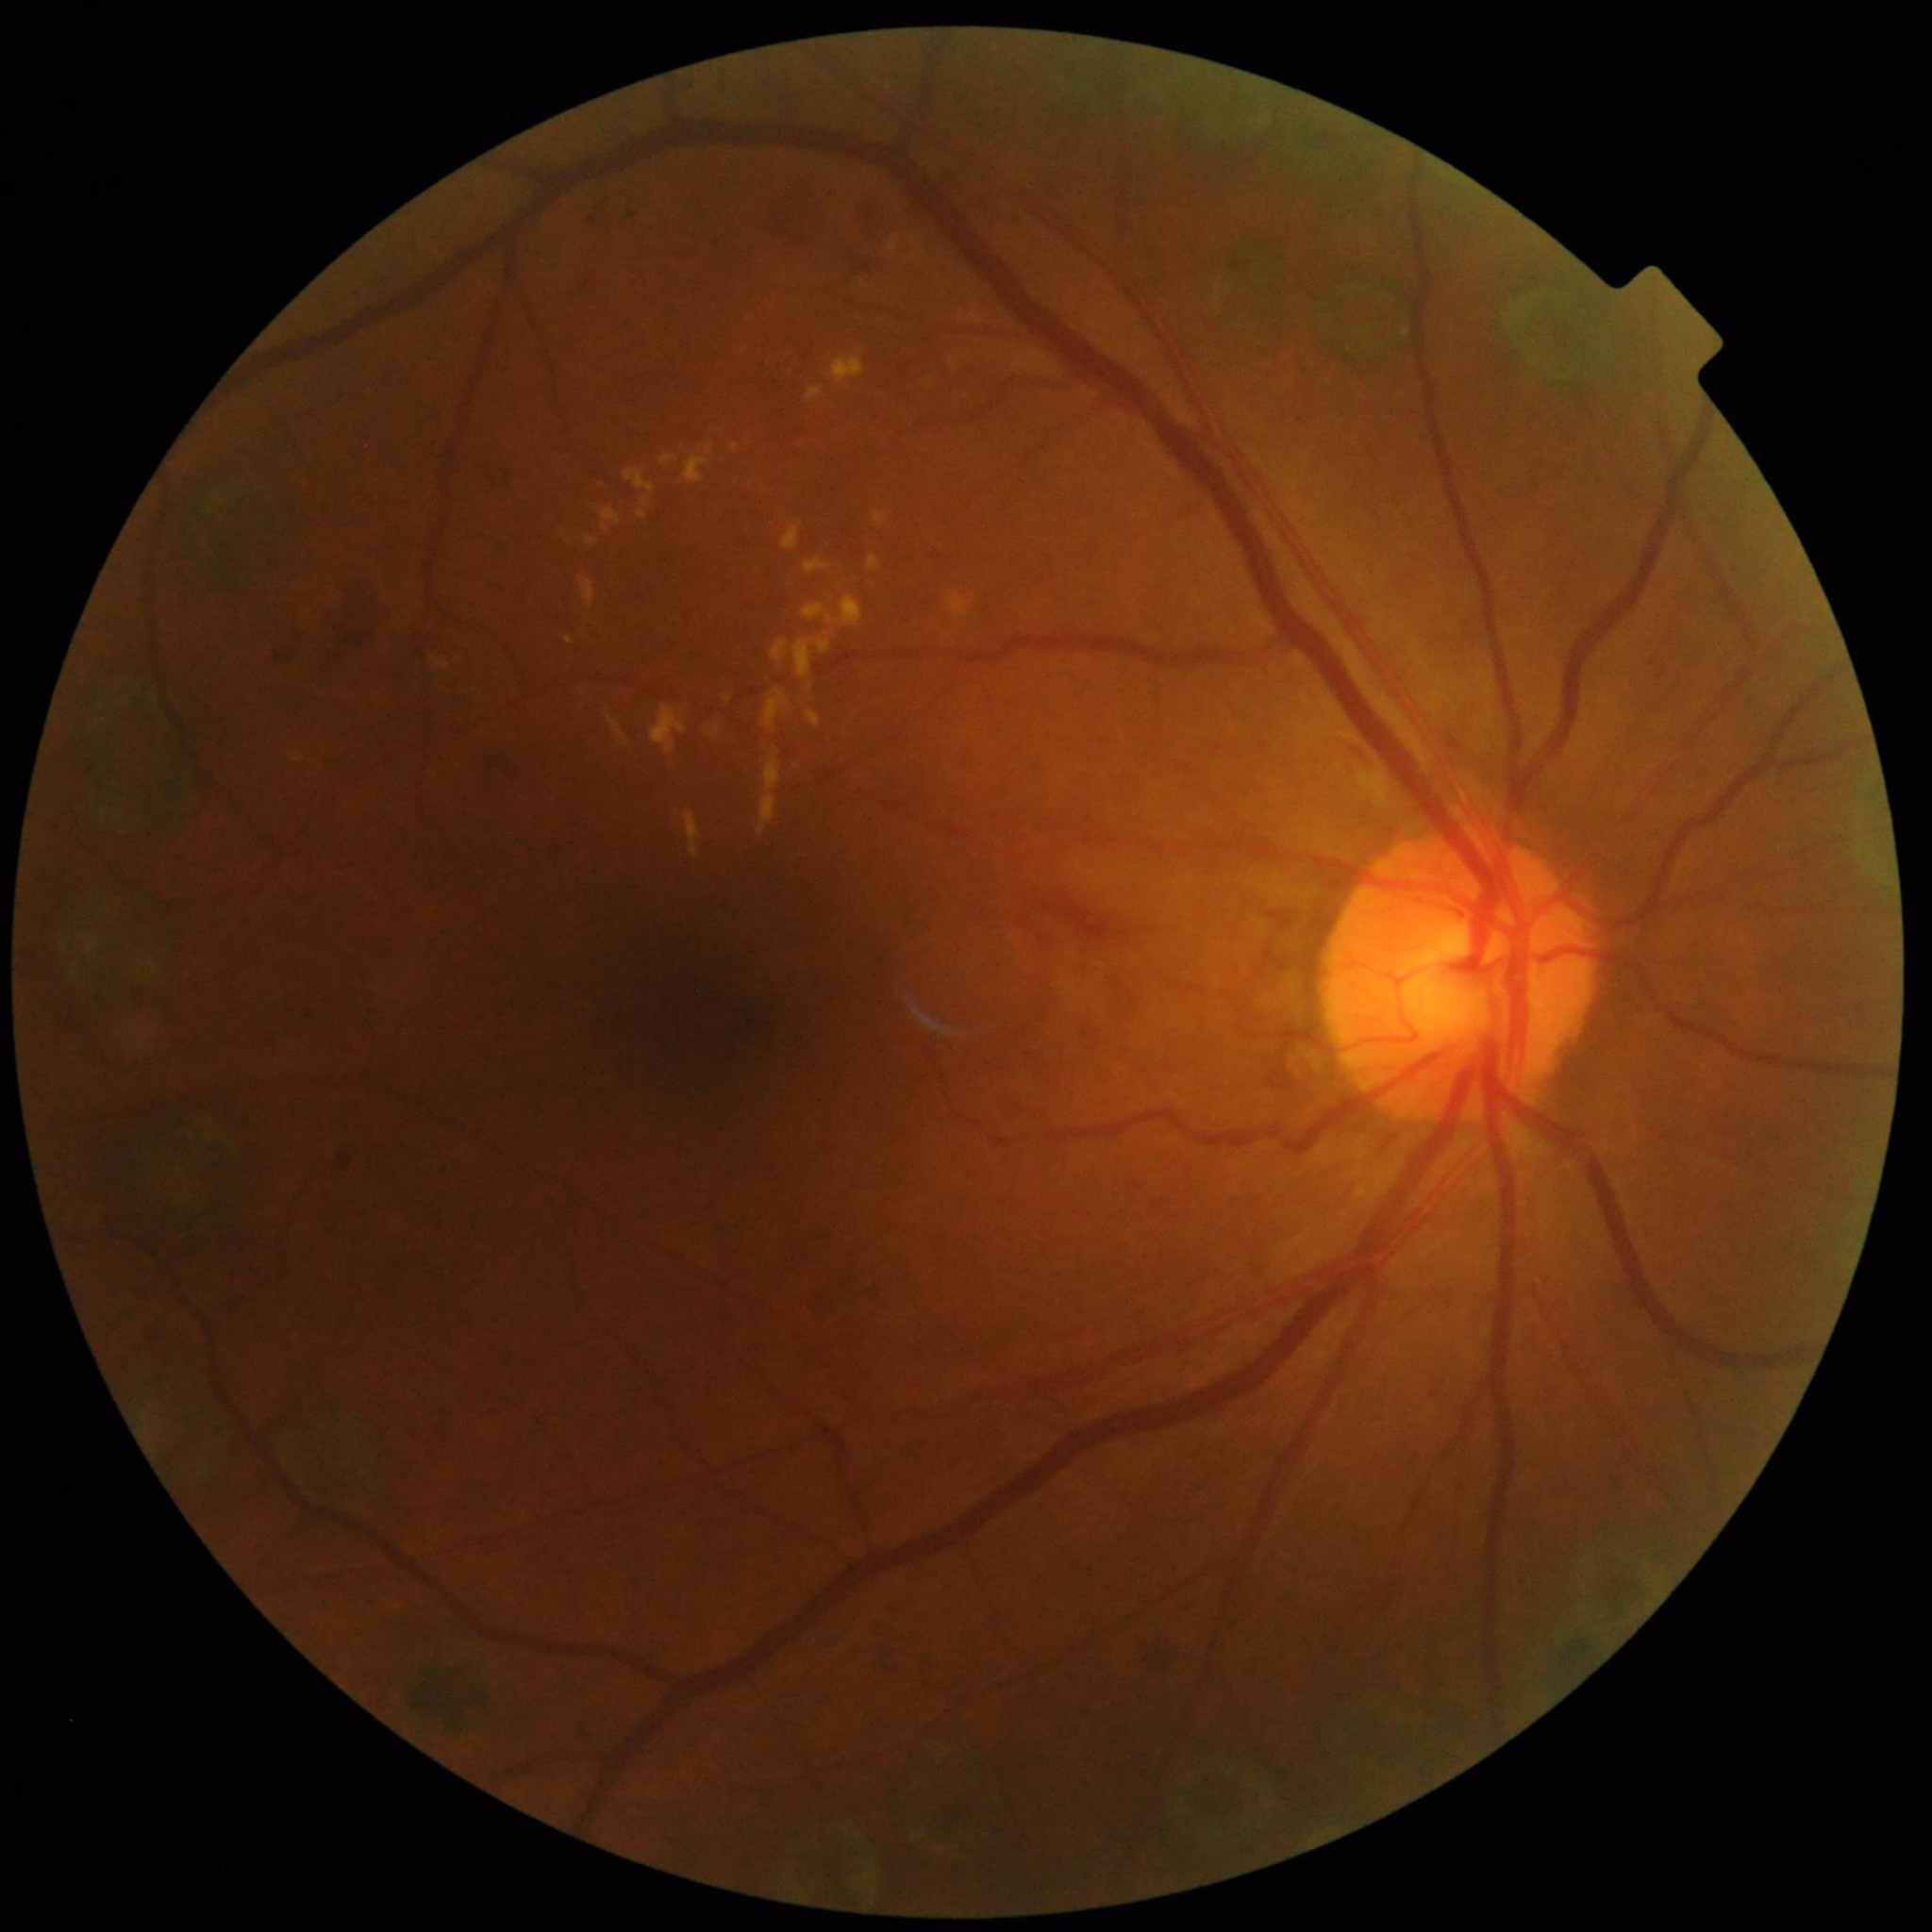
Patient diagnosed with diabetic retinopathy (DR).
Image quality: good.